2352x1568 · color fundus image.
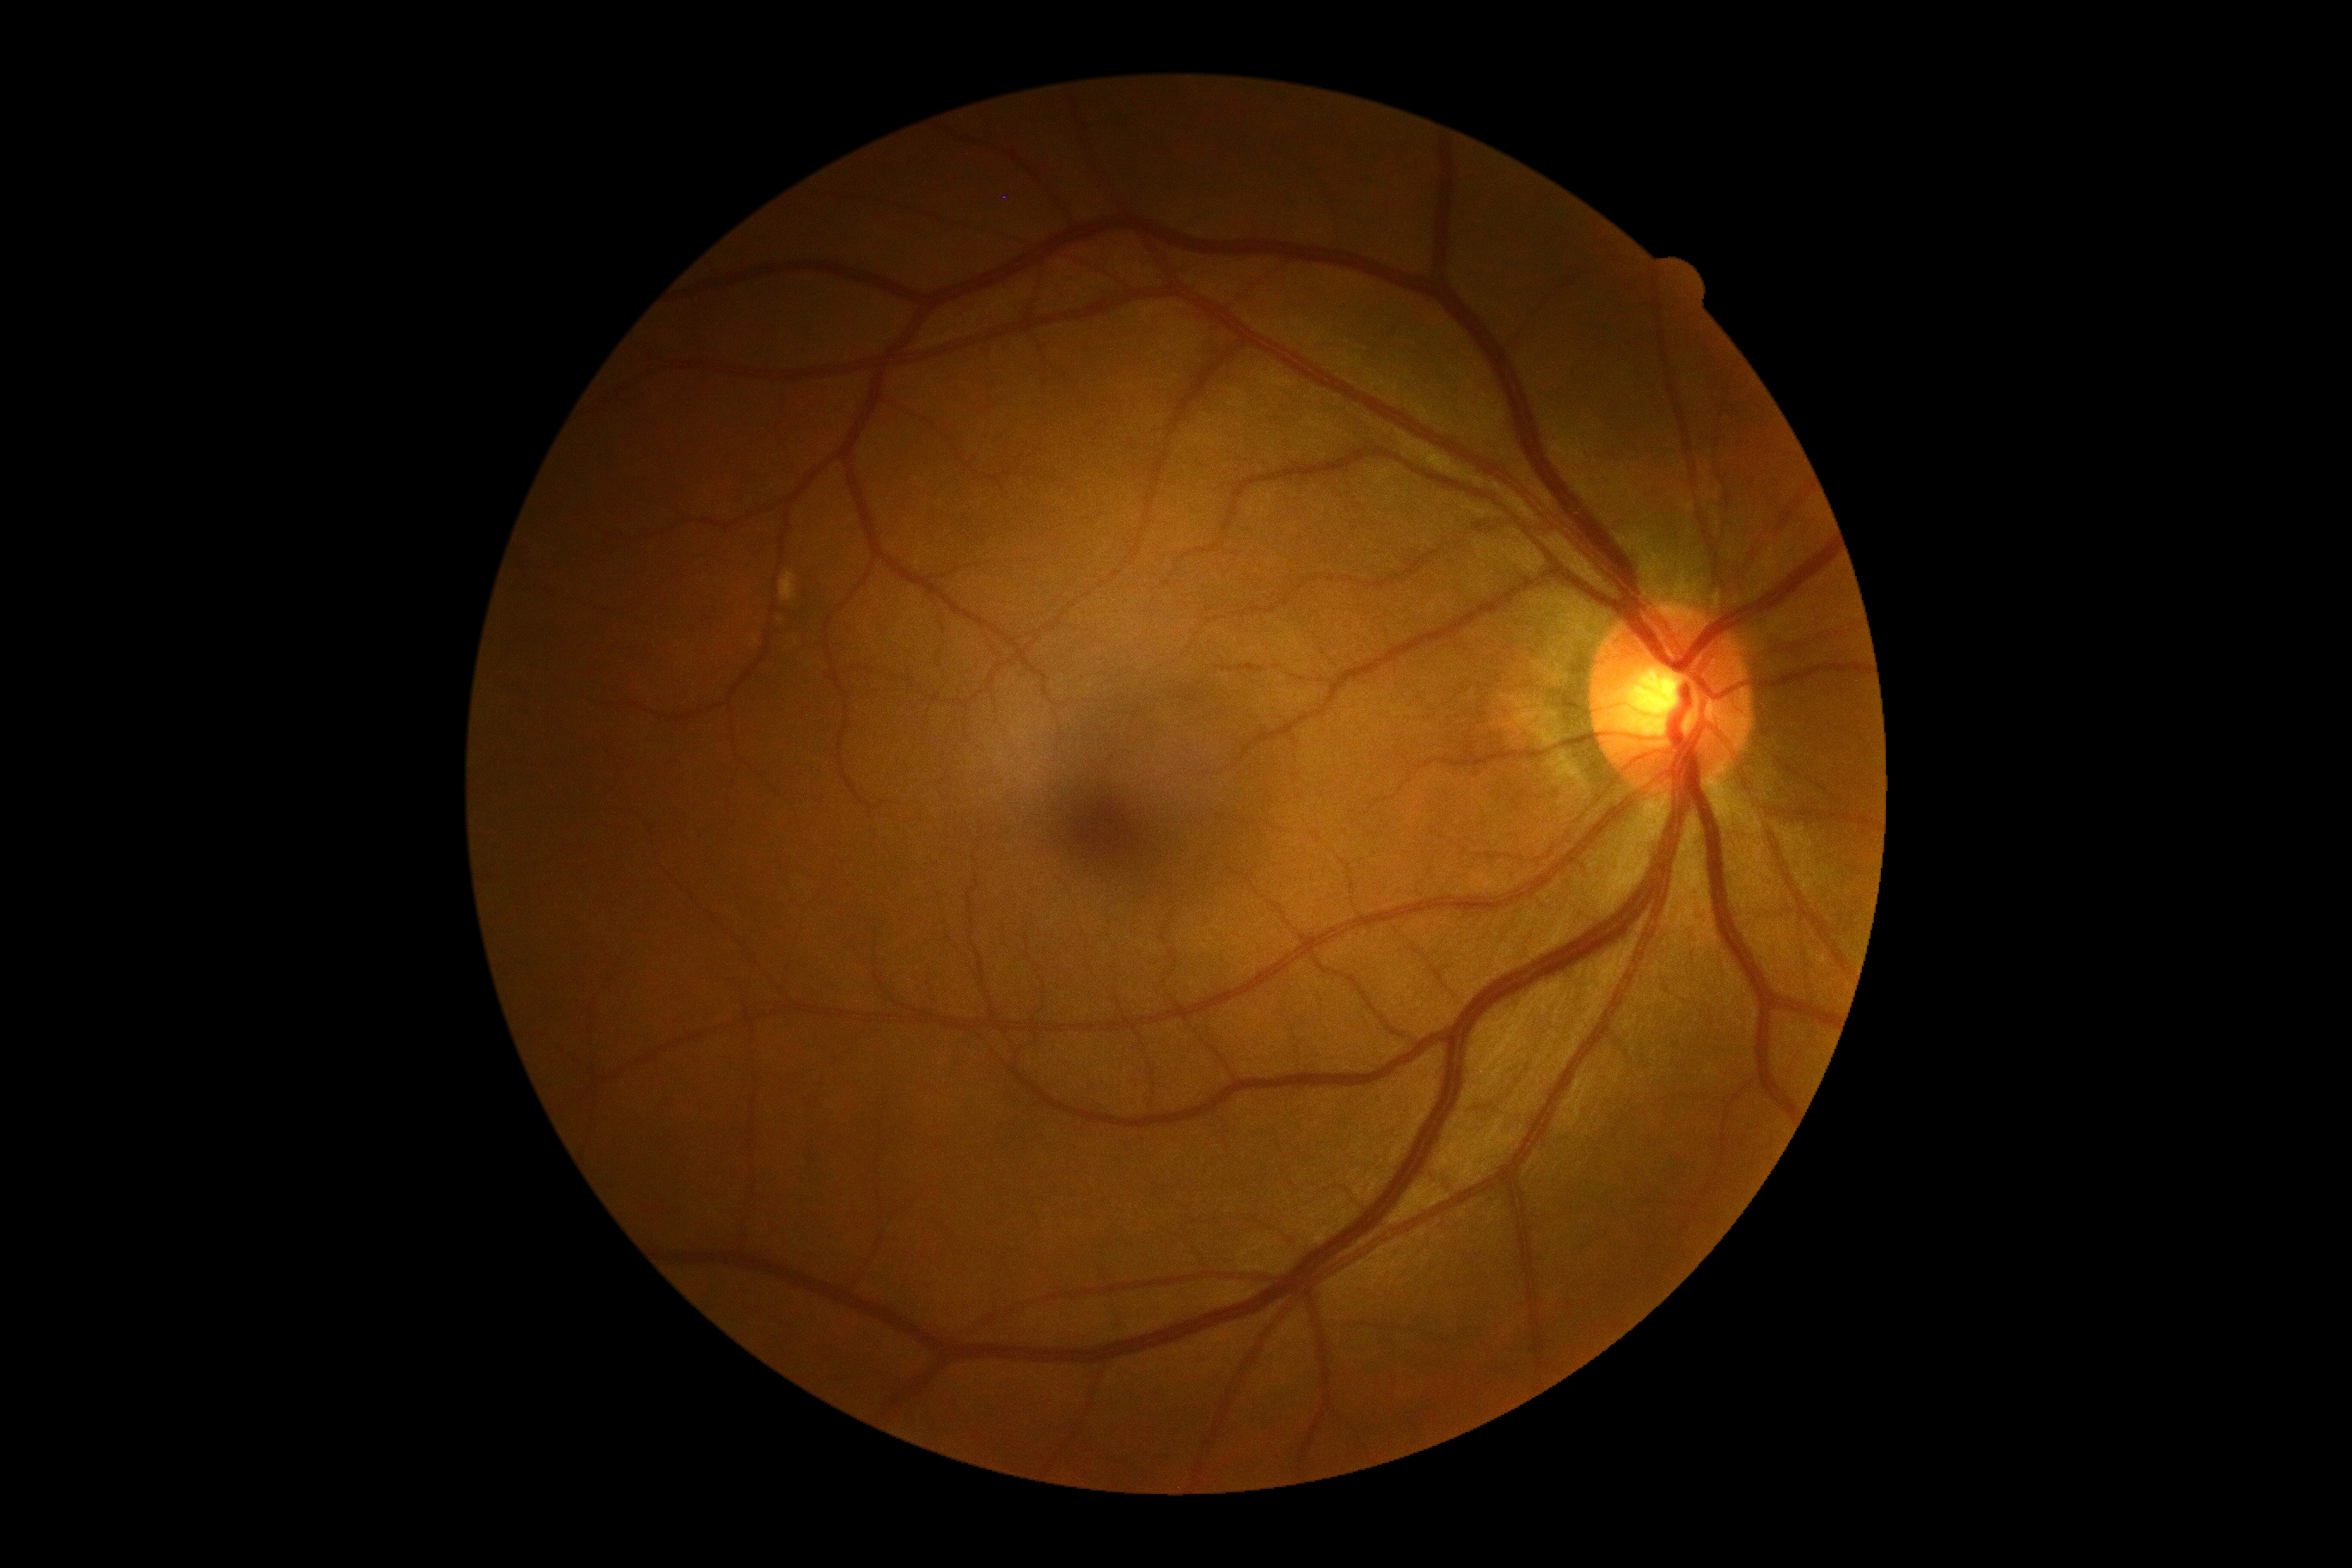
DR stage = grade 0 (no apparent retinopathy).